FOV: 45 degrees, camera: NIDEK AFC-230, no pharmacologic dilation — 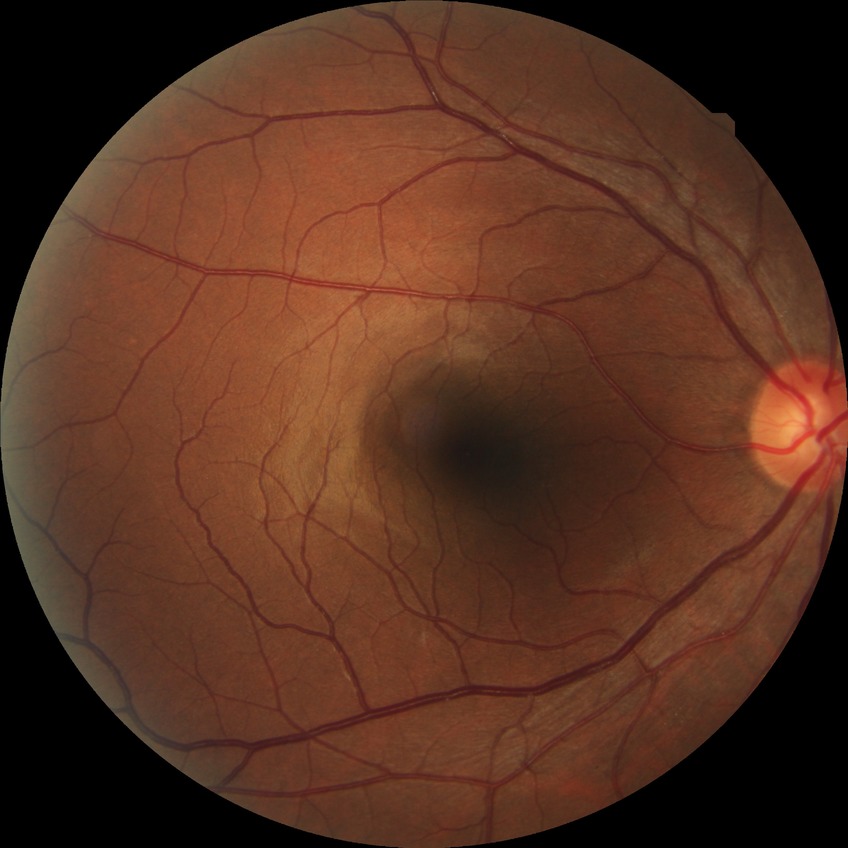 Diabetic retinopathy (DR) is no diabetic retinopathy (NDR).